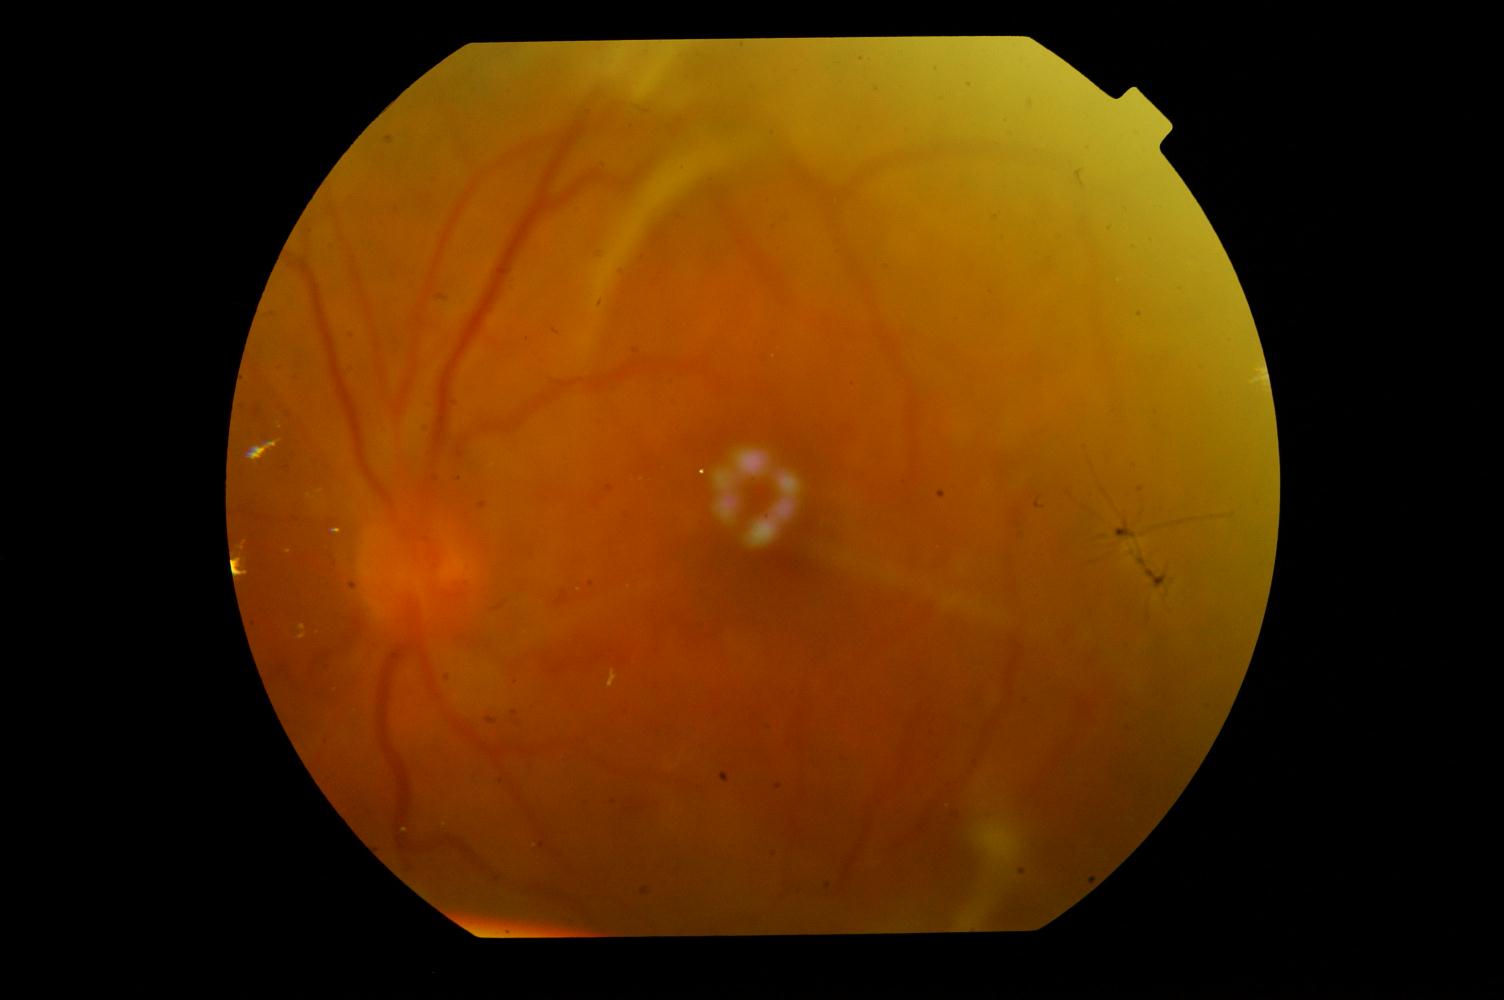 Fundus appearance consistent with diabetic retinopathy (DR).